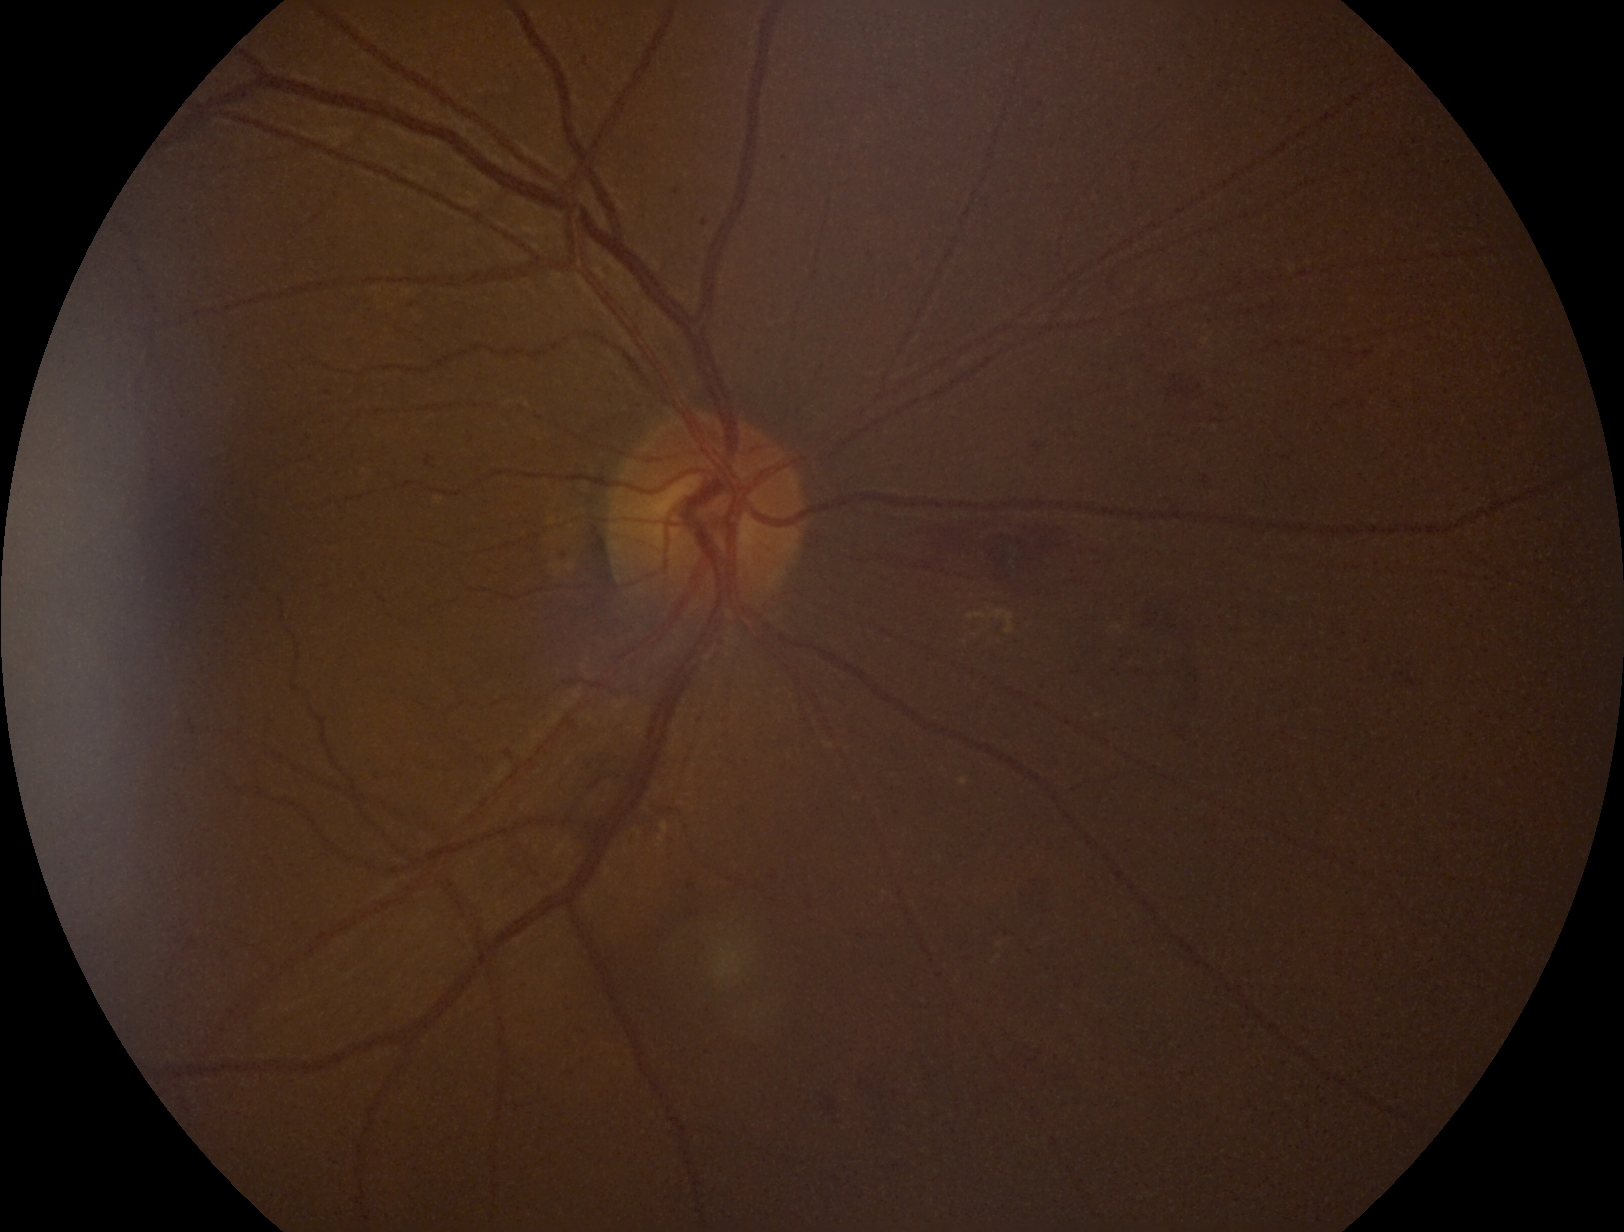 diabetic retinopathy (DR): moderate NPDR (grade 2), DR class: non-proliferative diabetic retinopathy.